45° field of view: 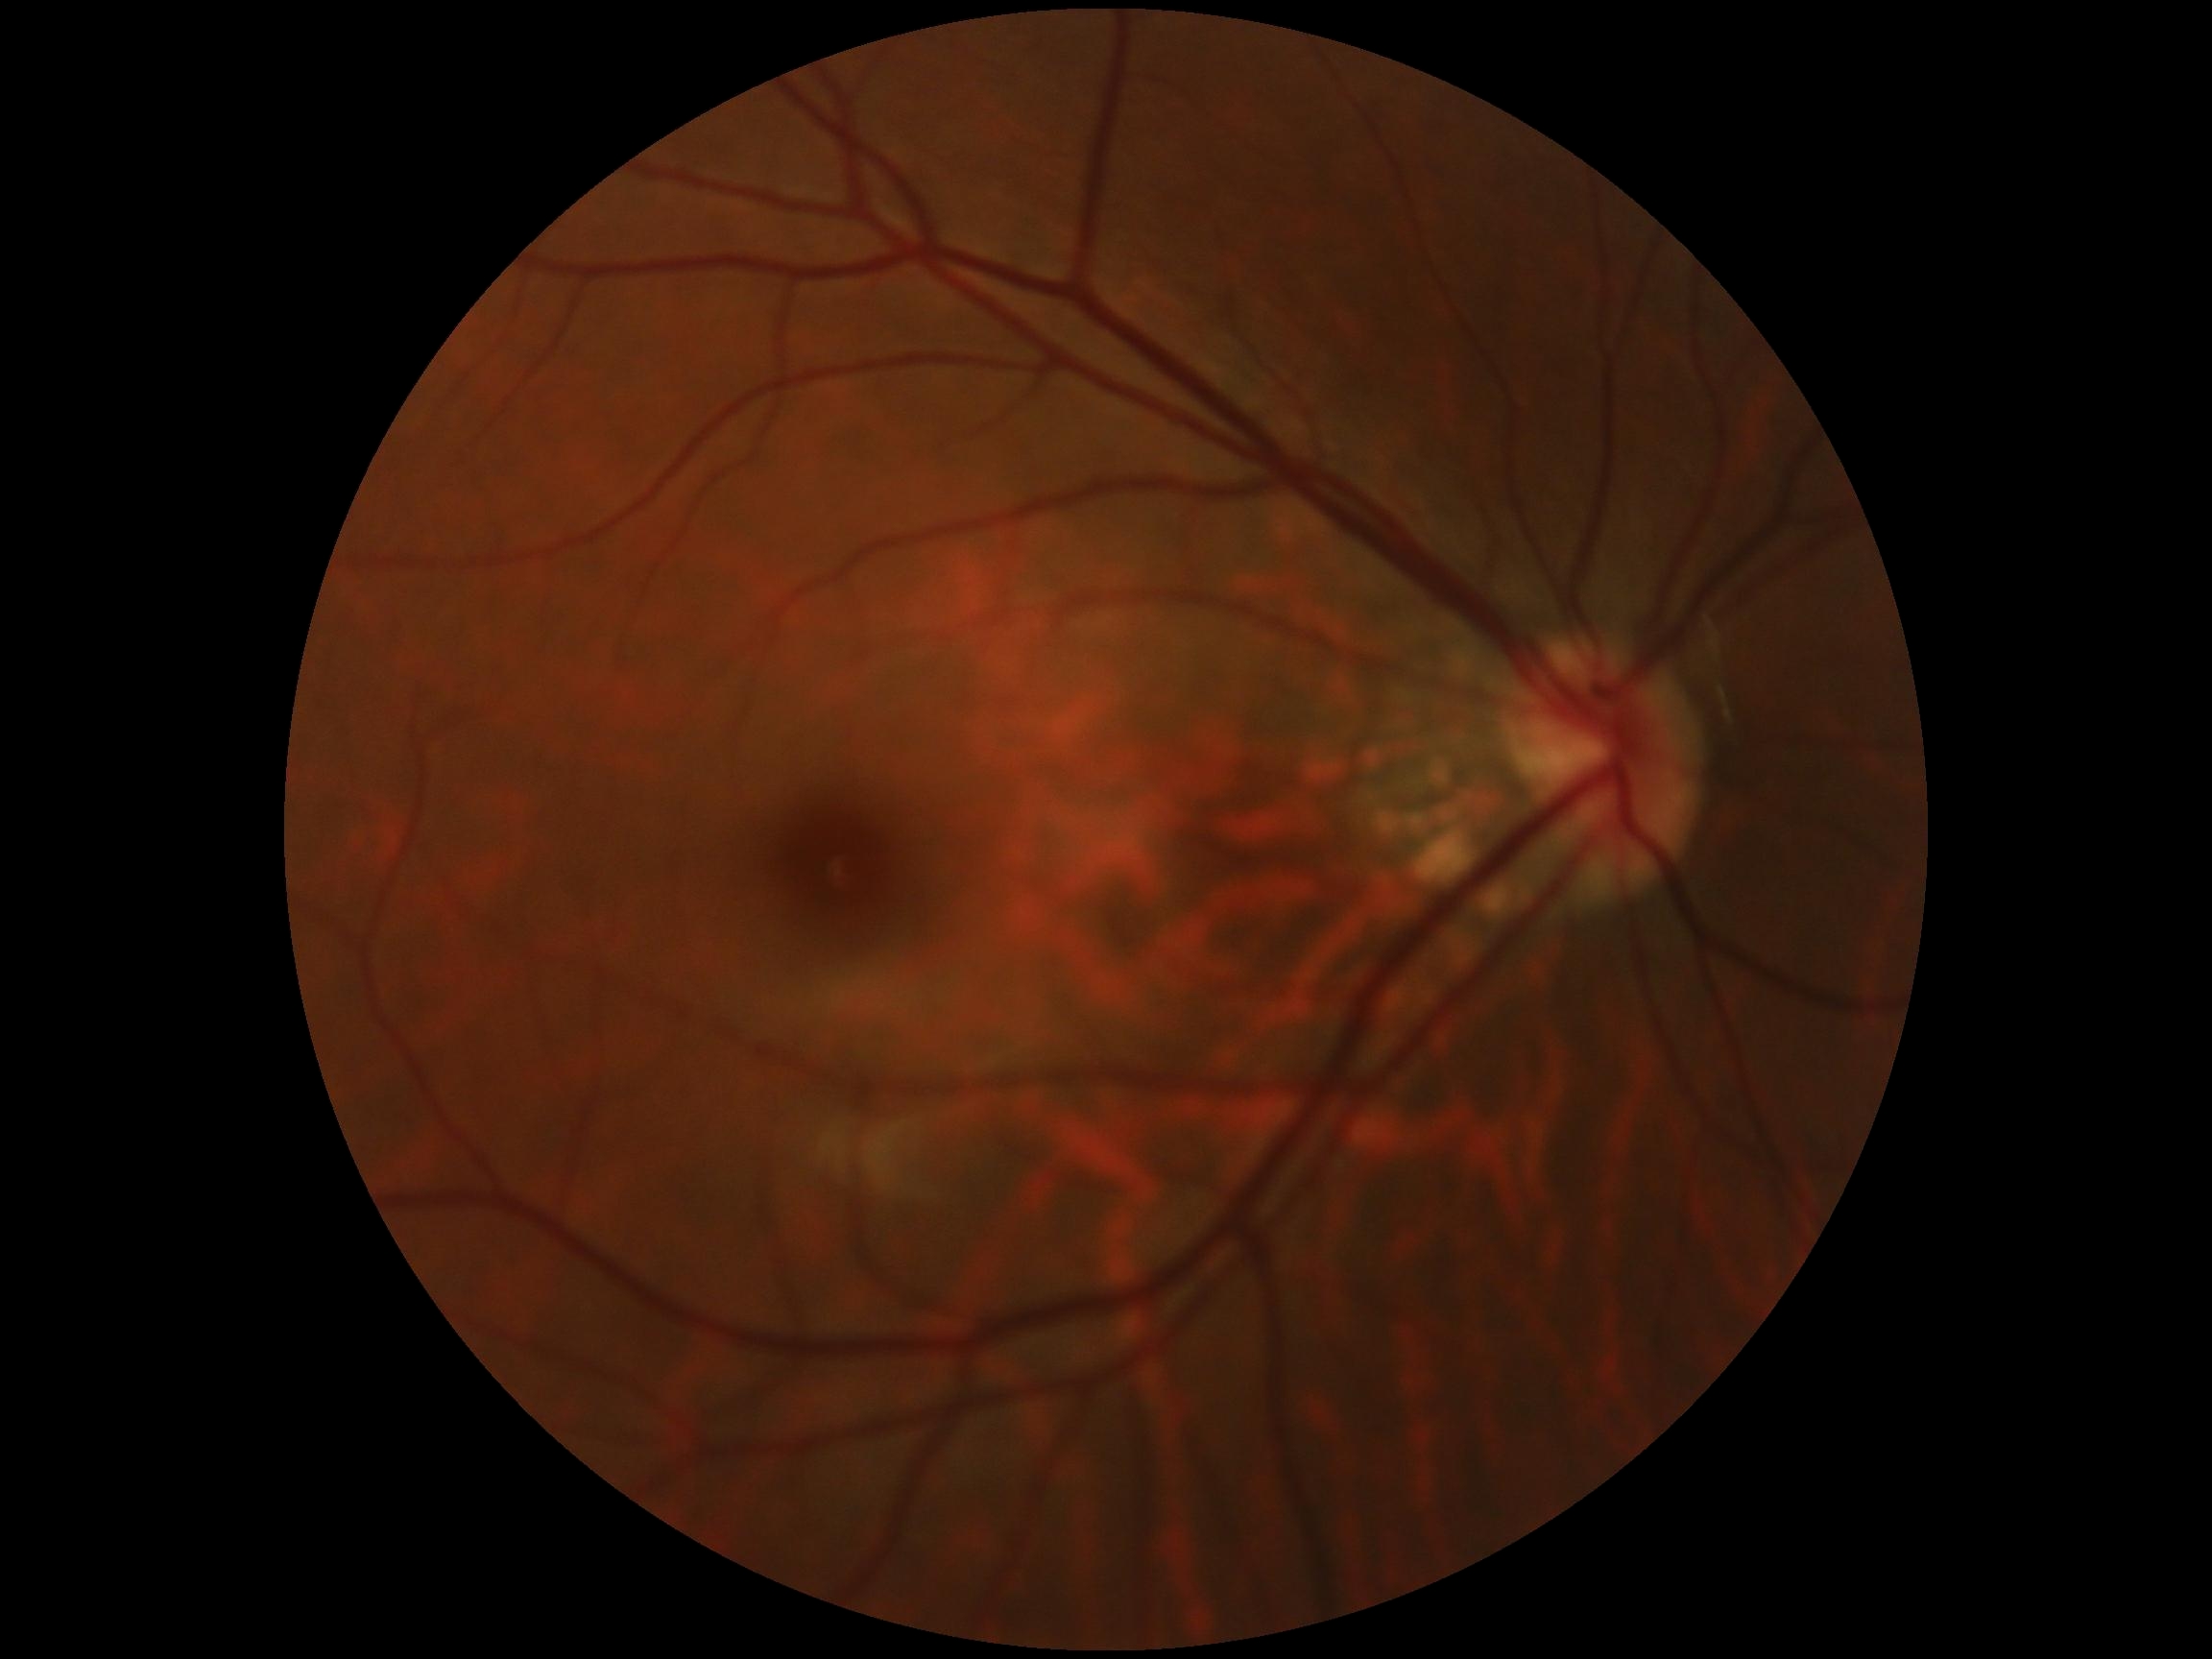 DR grade is 0.